45-degree field of view, NIDEK AFC-230, color fundus image, 848 x 848 pixels
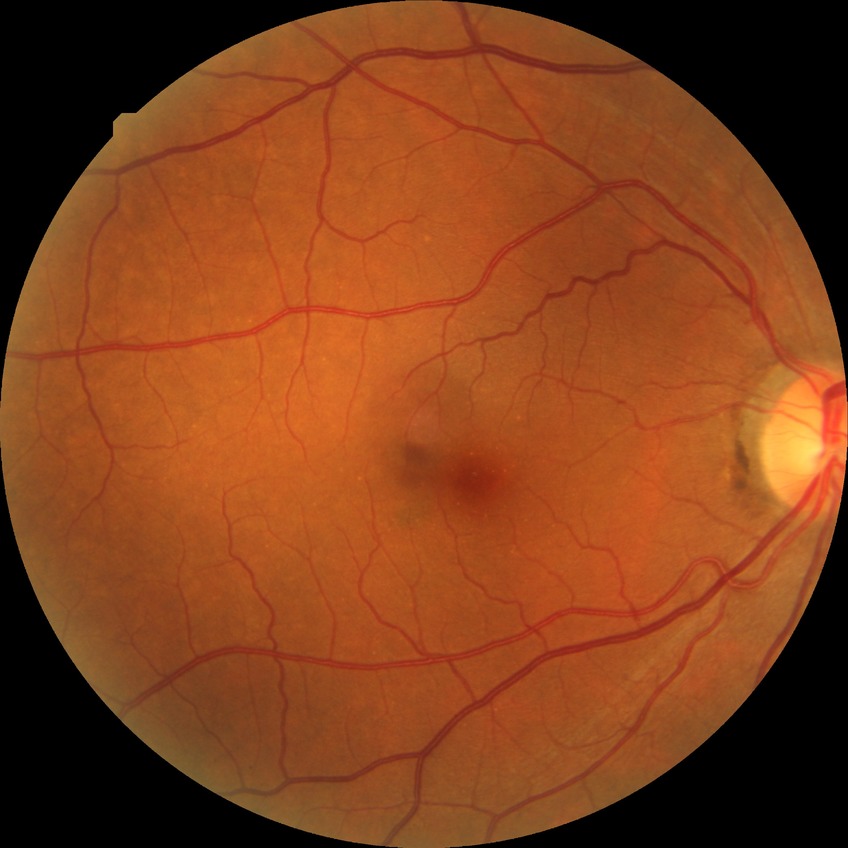 Annotations:
* diabetic retinopathy grade — no diabetic retinopathy